Optic disc at the center of the field:
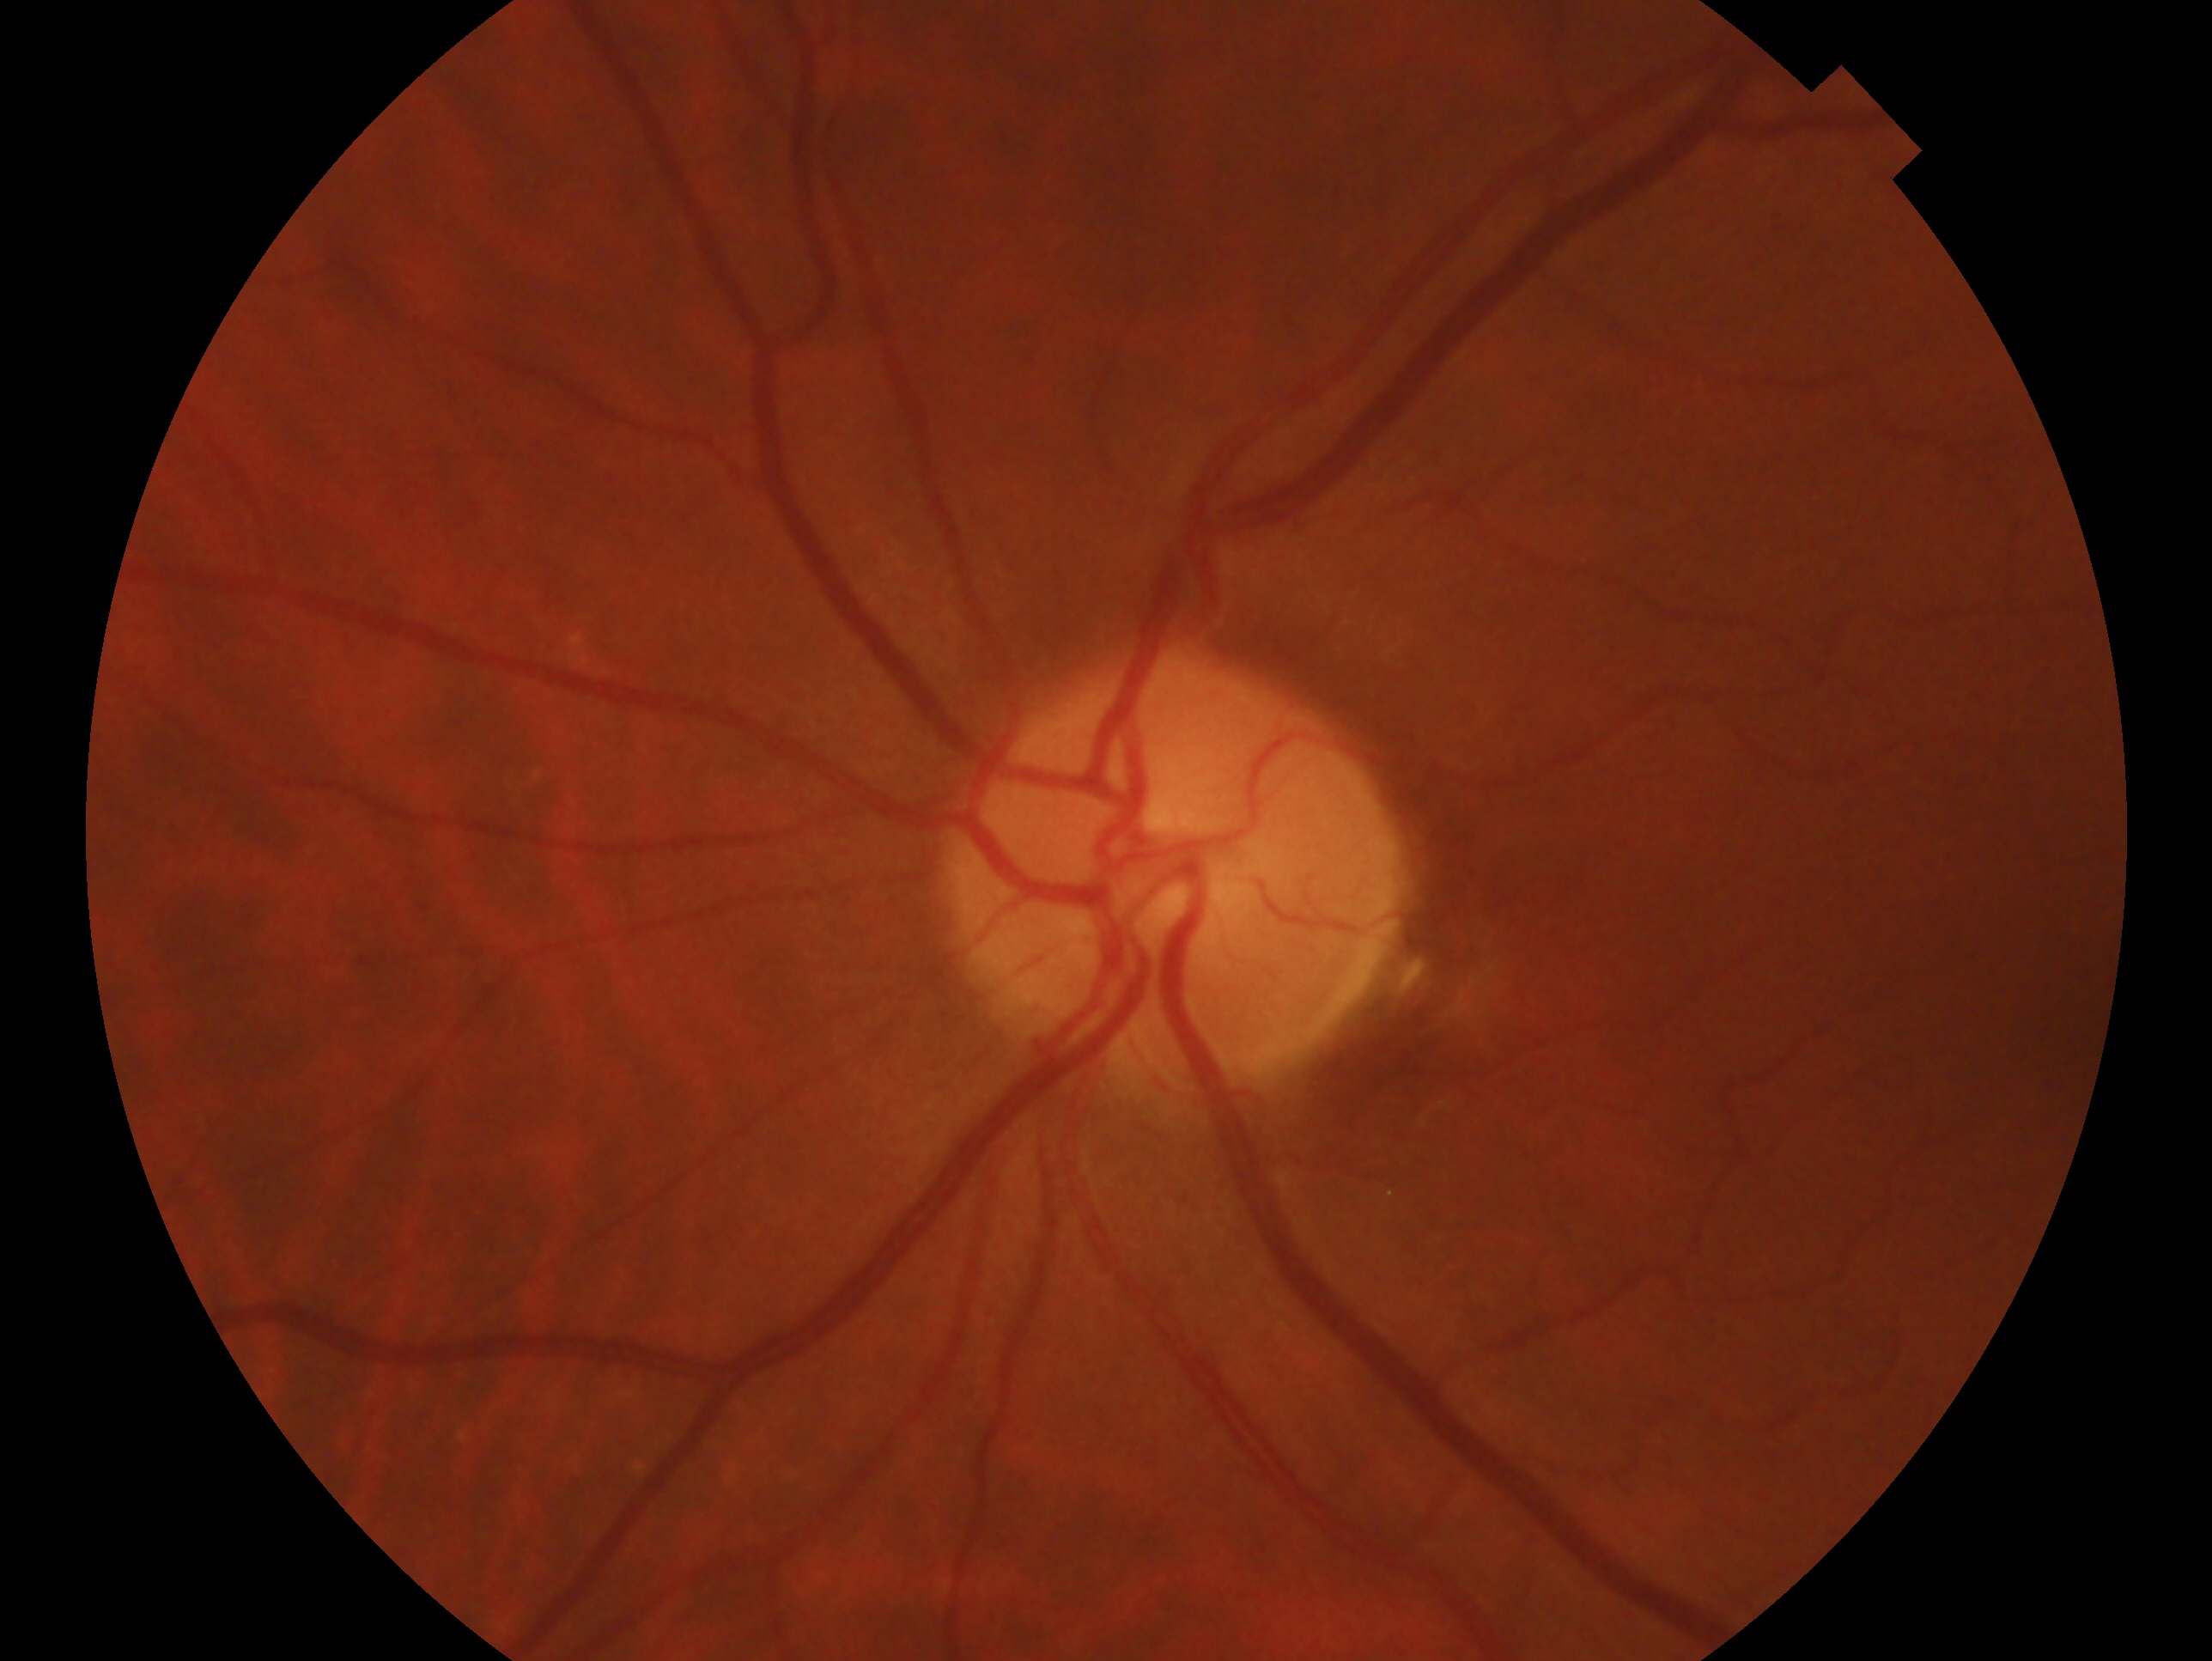 Annotations:
- diagnosis · no signs of glaucoma
- eye · OS